Wide-field contact fundus photograph of an infant; captured with the Clarity RetCam 3 (130° field of view)
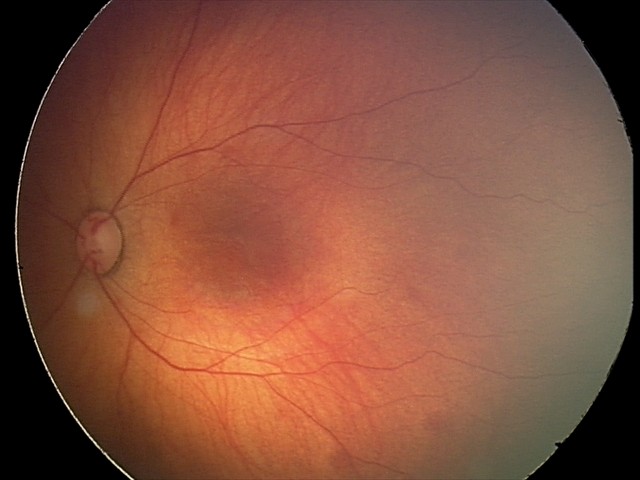 Series diagnosed as retinal hemorrhages.